Wide-field fundus photograph of an infant; 1240x1240: 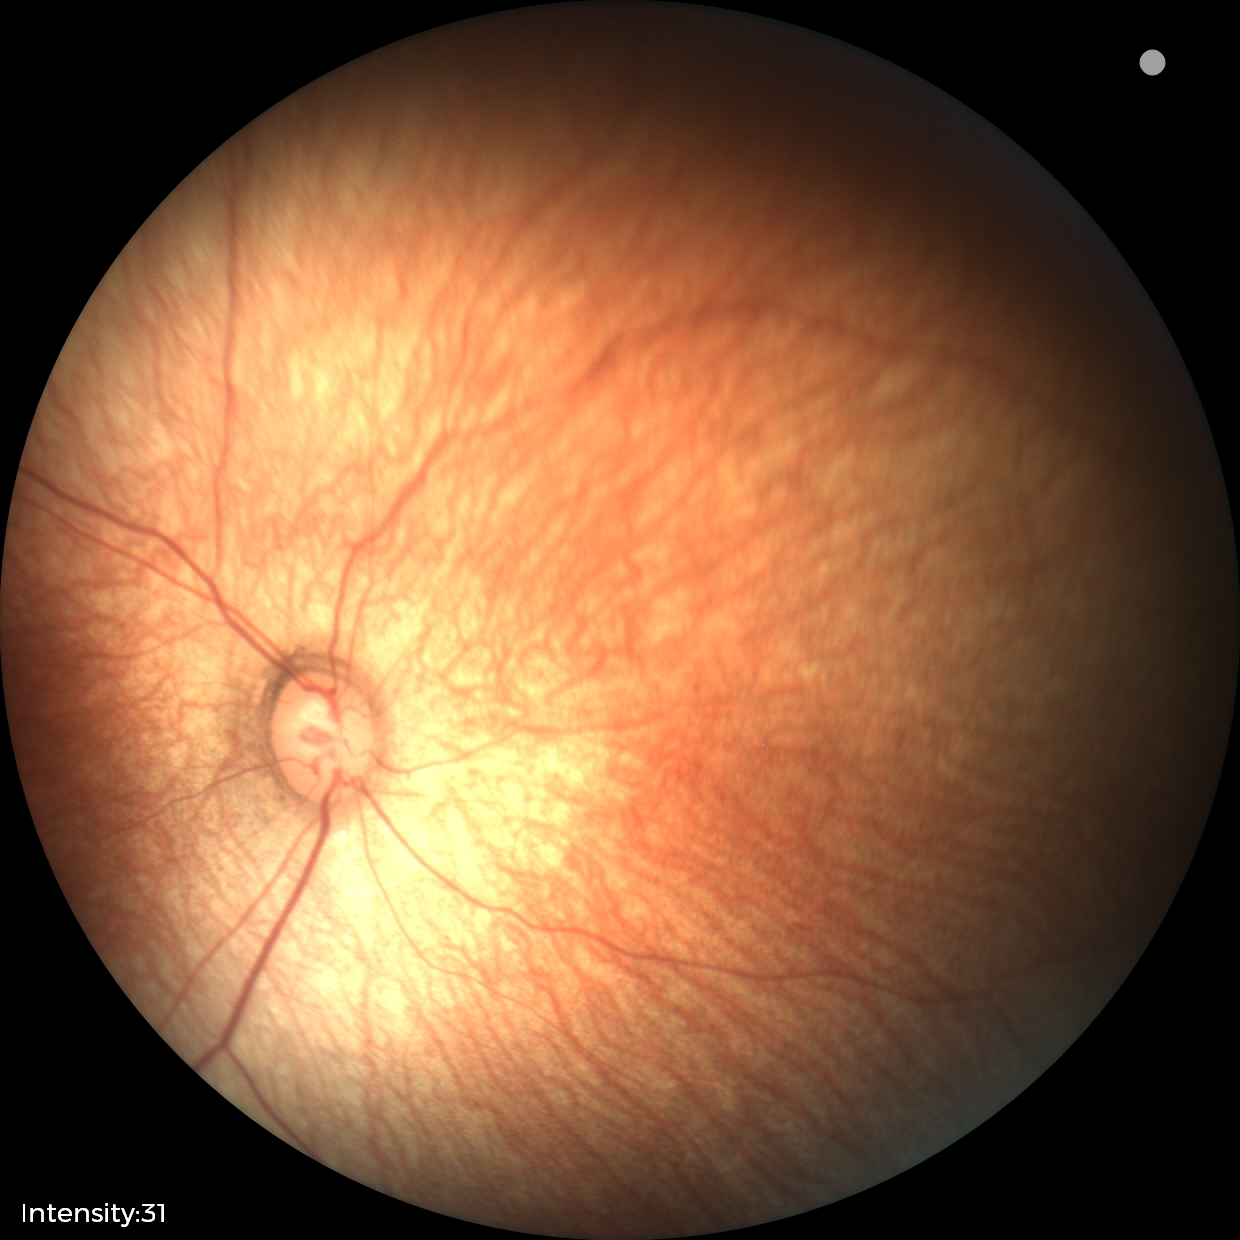

Assessment: normal.